2352 x 1568 pixels · FOV: 45 degrees:
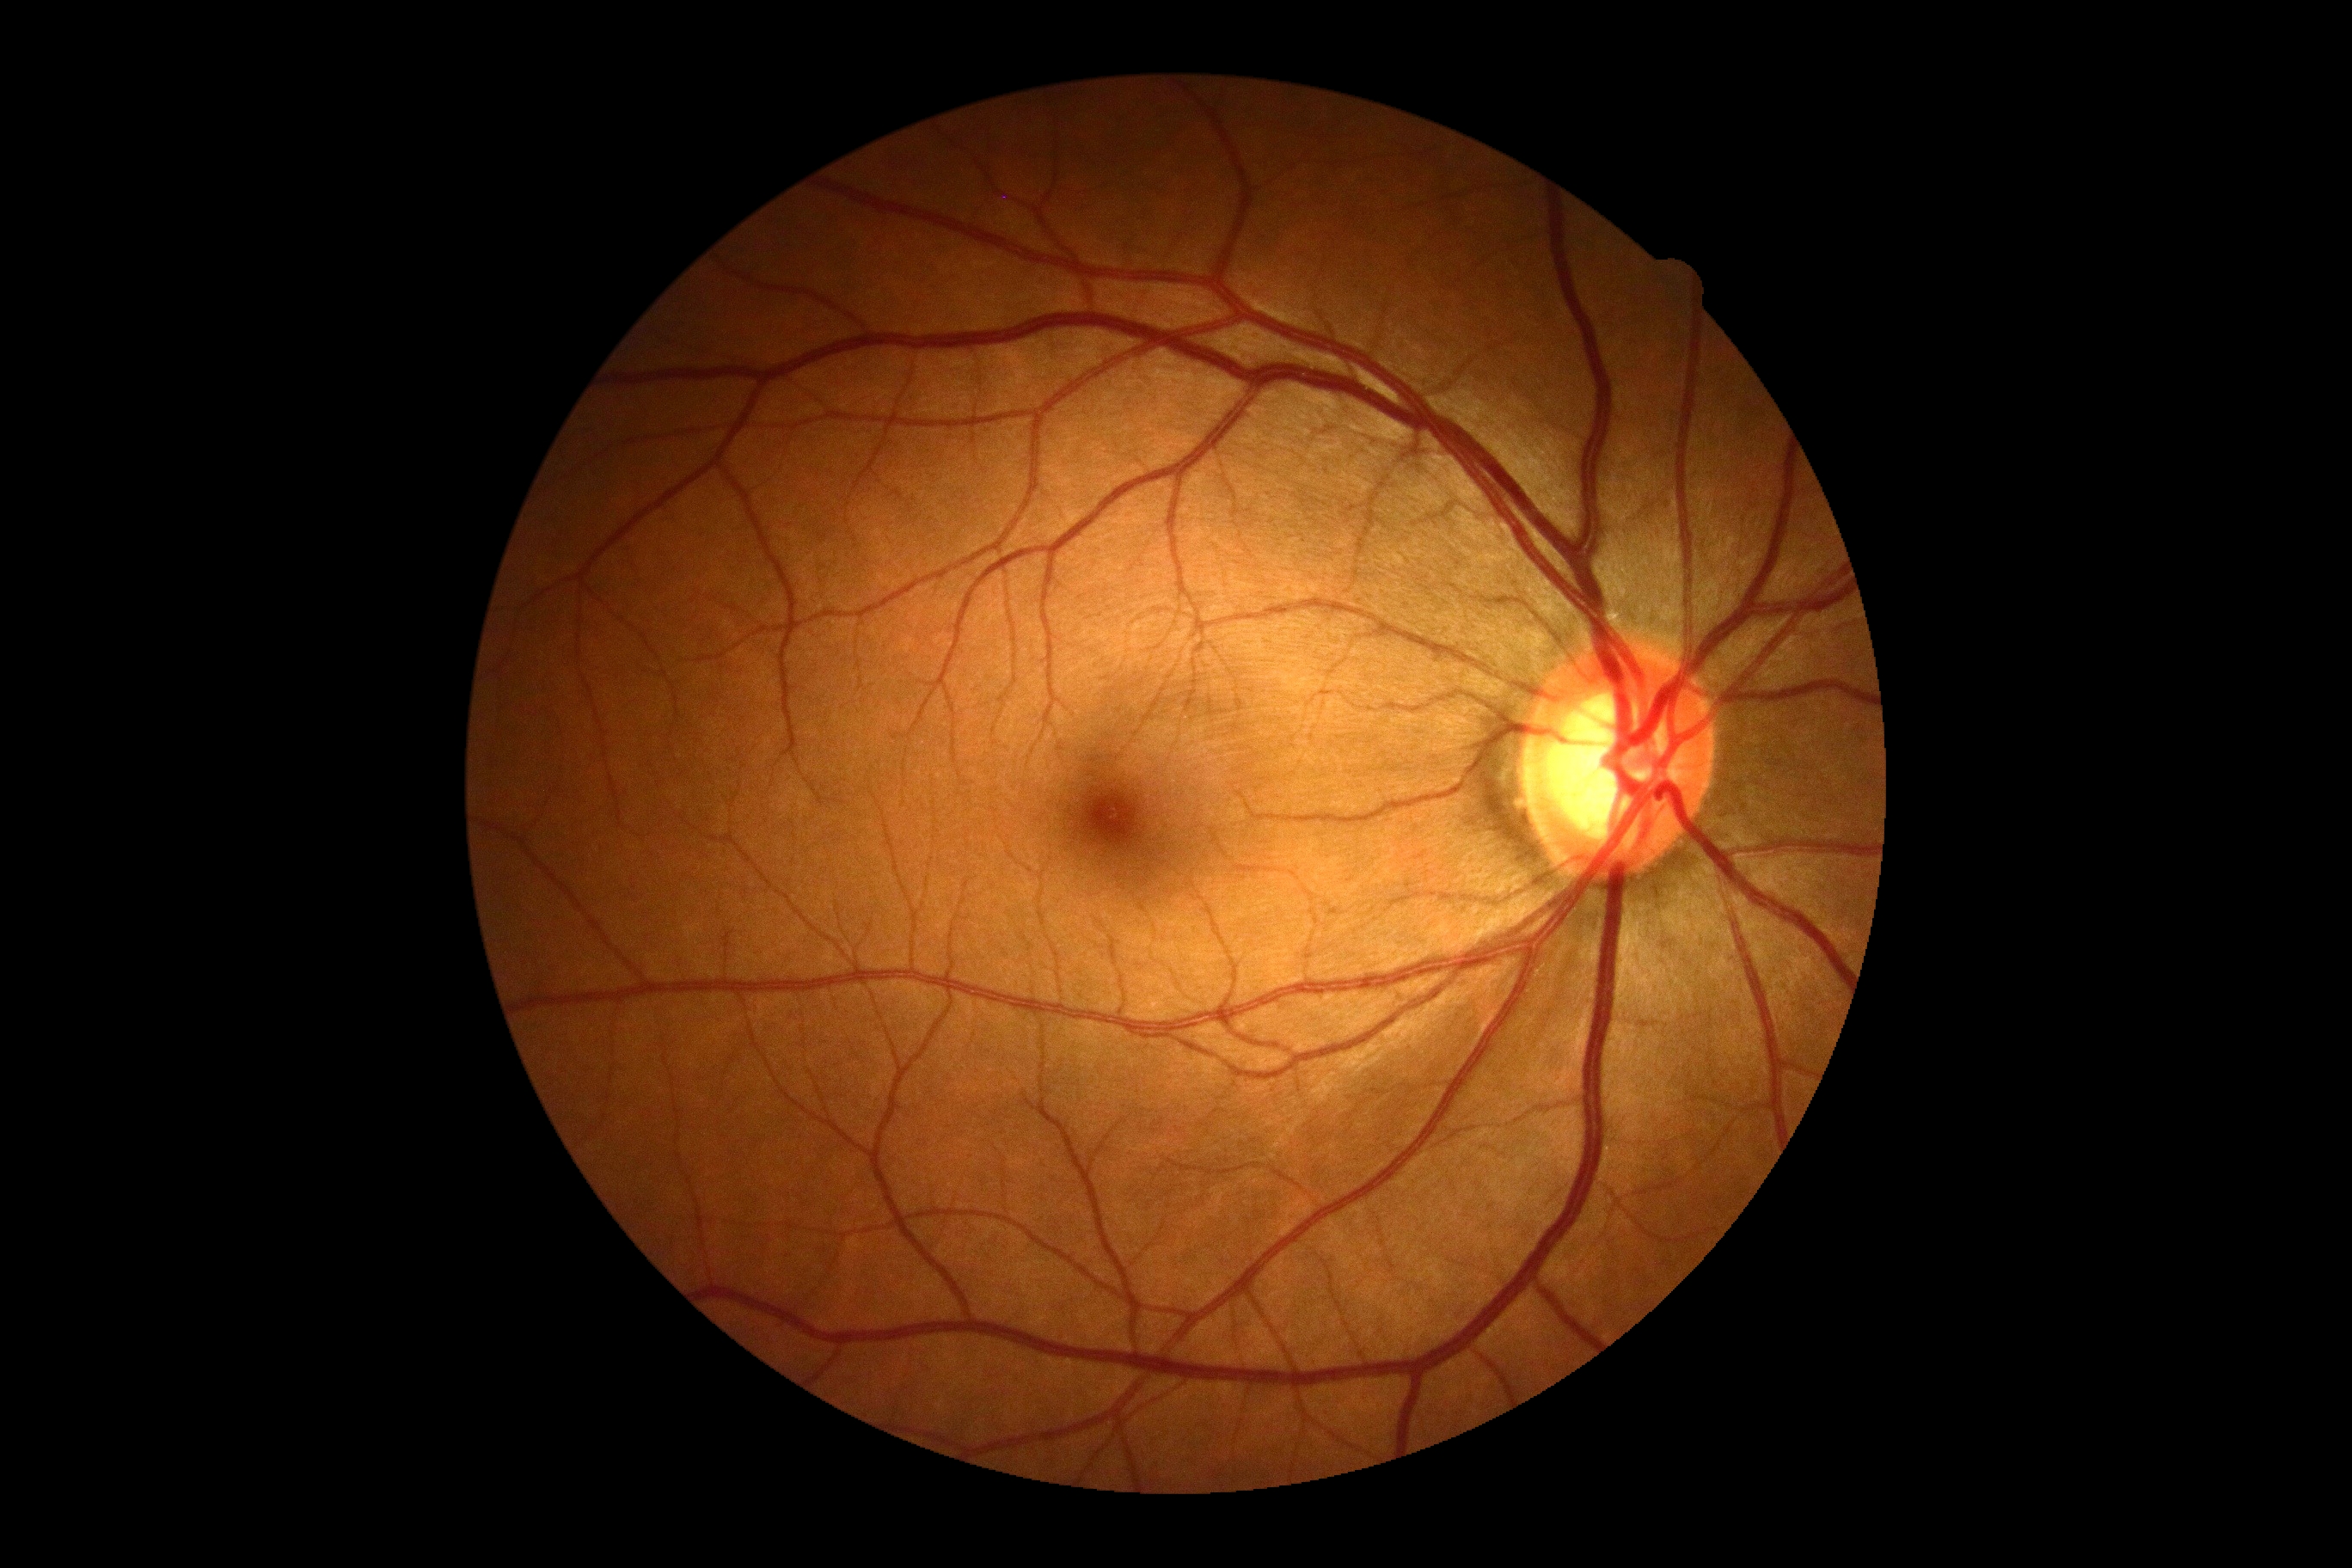

Findings:
- diabetic retinopathy: 0/4